Image size 2048x1536
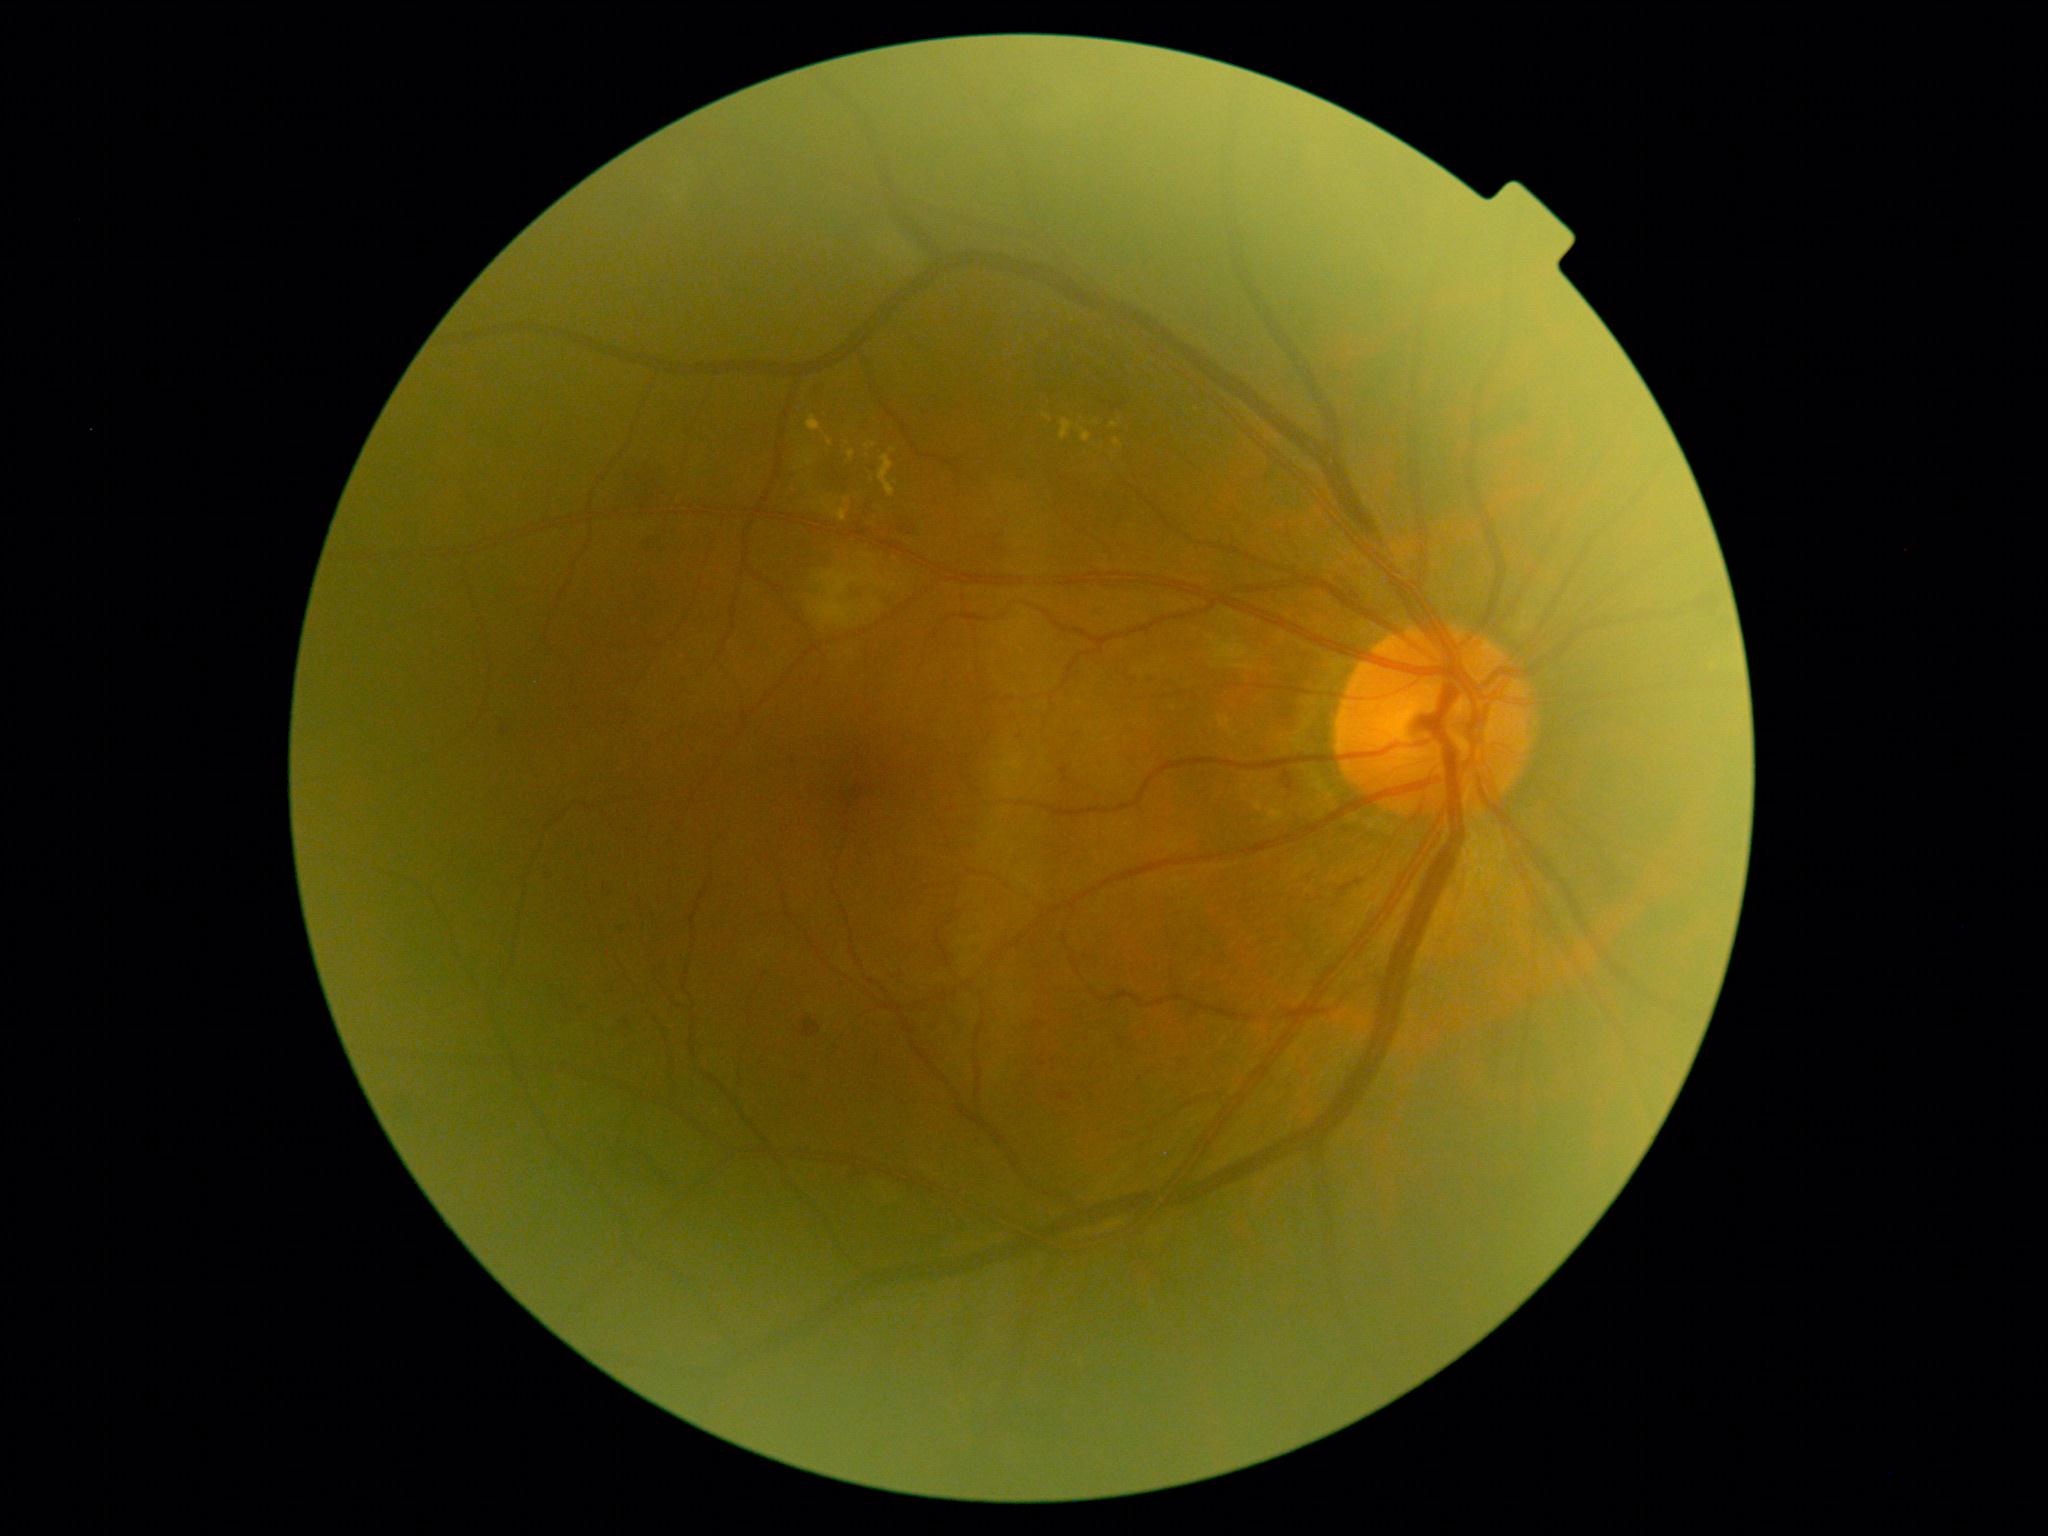

Diabetic retinopathy (DR) is grade 2 (moderate NPDR).
Hemorrhages (HEs) located at (1336, 579, 1359, 600); (867, 505, 873, 513); (854, 1172, 867, 1188); (897, 523, 920, 535); (801, 1018, 821, 1038); (1277, 773, 1293, 795).
Microaneurysms (MAs) located at (640, 538, 656, 555); (626, 1021, 630, 1030); (500, 727, 508, 736); (1058, 1093, 1074, 1102); (1059, 766, 1072, 785); (547, 876, 554, 885).
MAs (small, approximate centers) near 605:888; 566:1007; 1020:737; 1141:1079; 801:1078.
Soft exudates (SEs) include (814, 570, 867, 627); (871, 599, 880, 608).
SEs (small, approximate centers) near 877:585; 893:588; 872:577.
Hard exudates (EXs) located at (1059, 420, 1075, 440); (1044, 414, 1052, 422); (823, 501, 849, 522); (1114, 439, 1124, 448); (804, 459, 813, 466); (879, 455, 897, 498); (864, 443, 876, 450); (1111, 423, 1120, 429); (848, 450, 856, 460); (807, 416, 821, 432); (1078, 426, 1092, 443).
EXs (small, approximate centers) near 894:451; 847:443; 846:502; 1096:423; 830:442.